Optic nerve head crop, acquired with a Nidek AFC-330 — 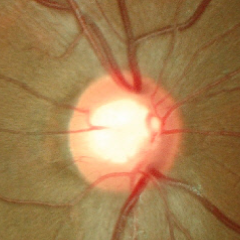

Impression = no glaucomatous changes.